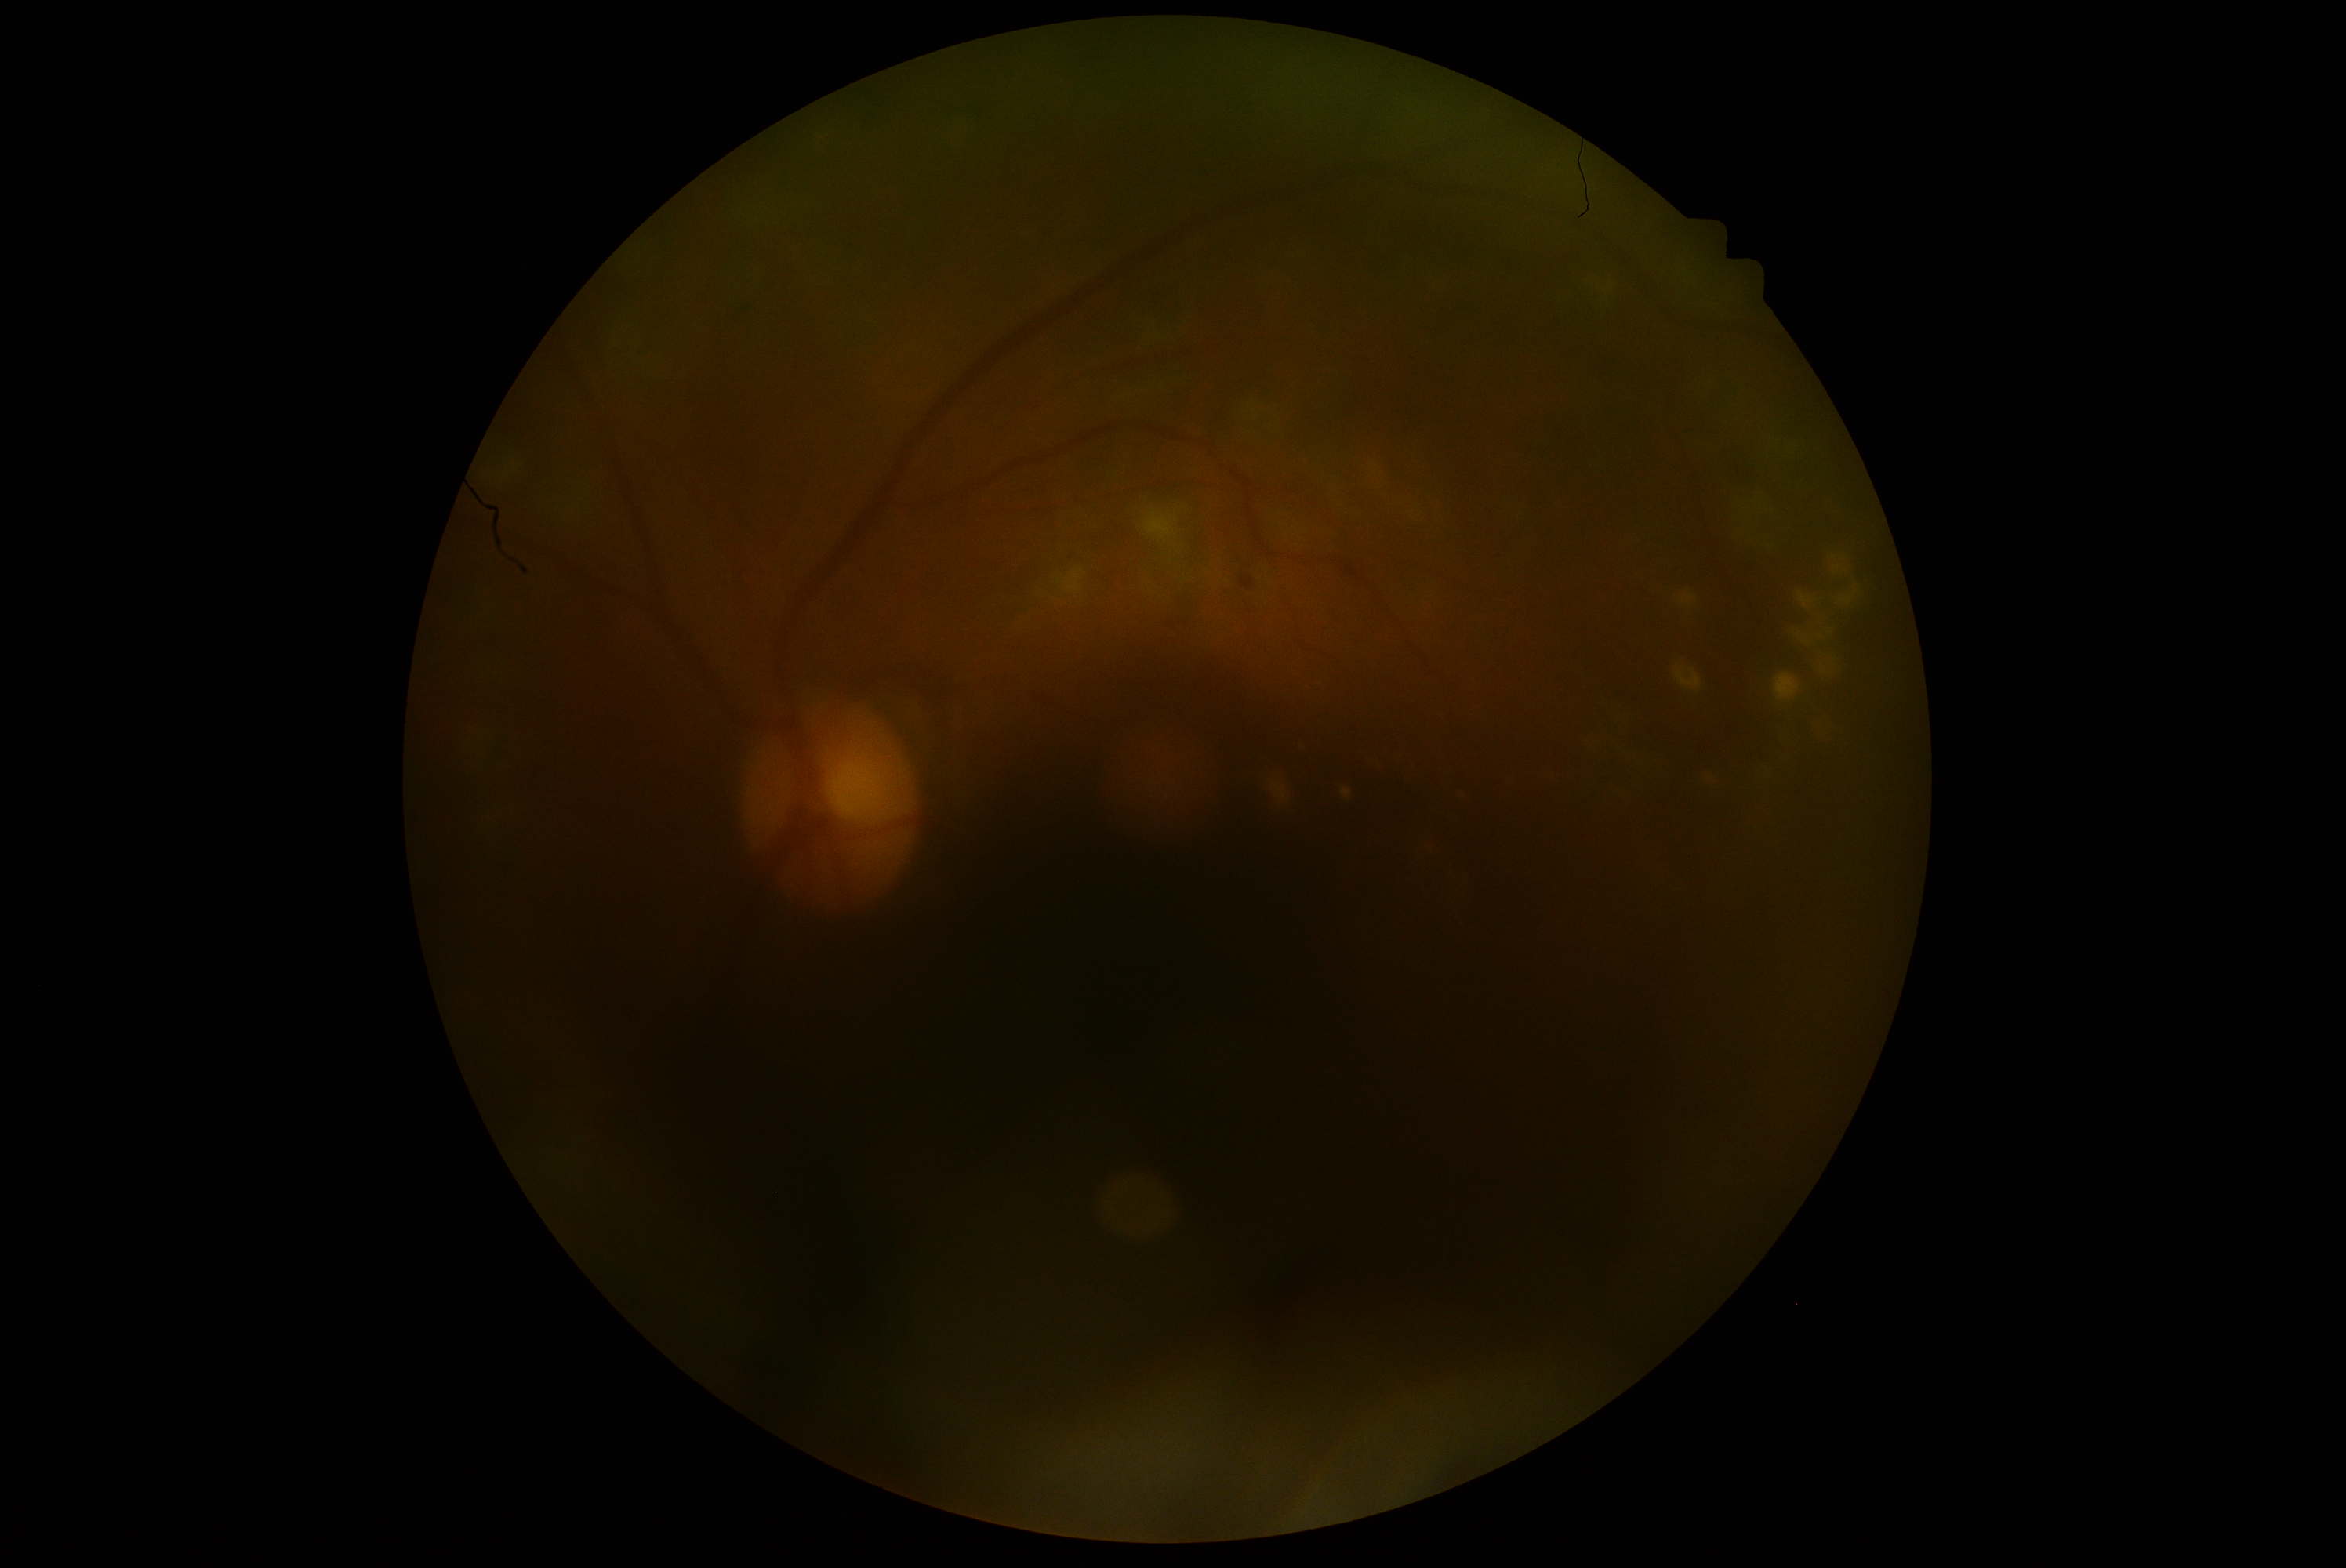
diabetic retinopathy grade@moderate NPDR (2).